Graded on the modified Davis scale · 45° field of view.
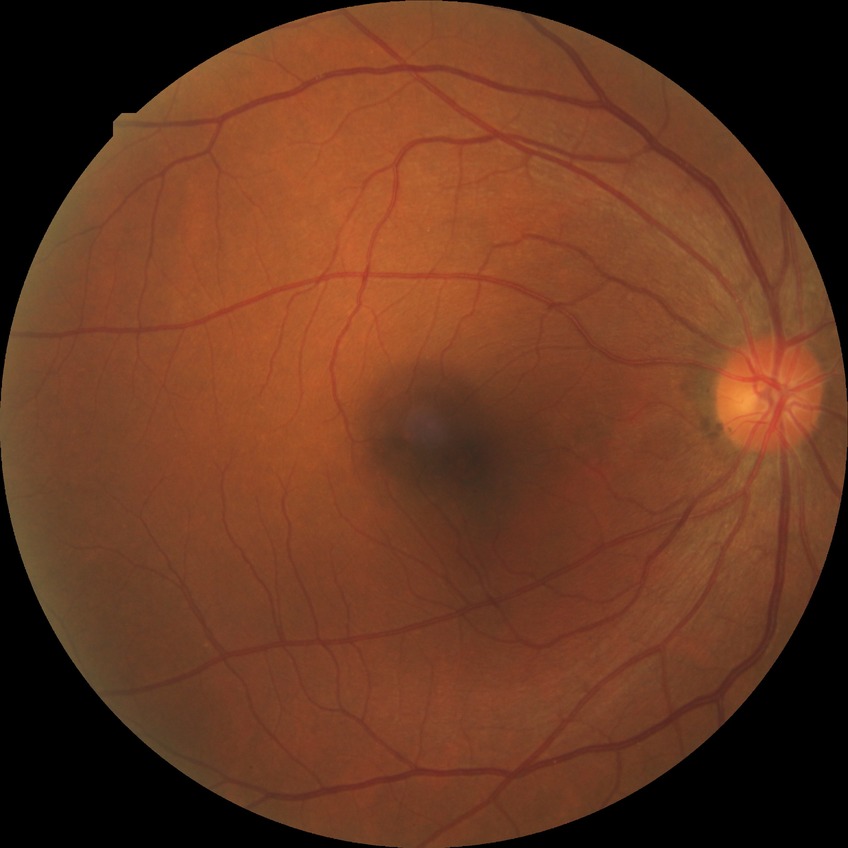

Diabetic retinopathy (DR): NDR (no diabetic retinopathy).